Modified Davis grading; retinal fundus photograph; nonmydriatic; FOV: 45 degrees; NIDEK AFC-230 — 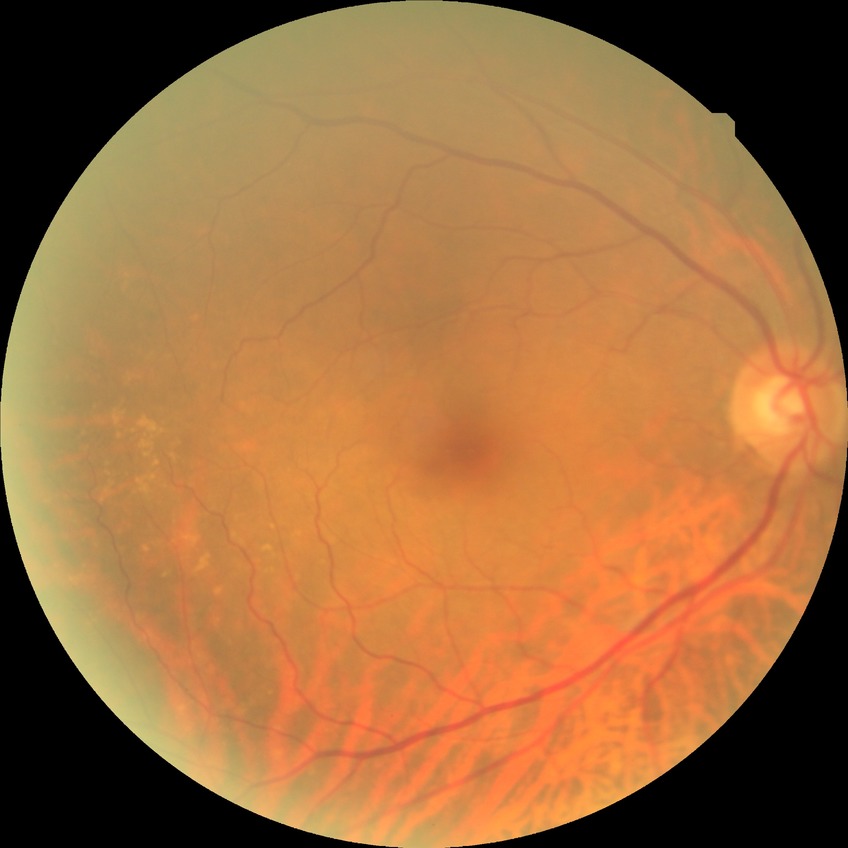
diabetic retinopathy (DR): NDR (no diabetic retinopathy).